Diabetic retinopathy graded by the modified Davis classification
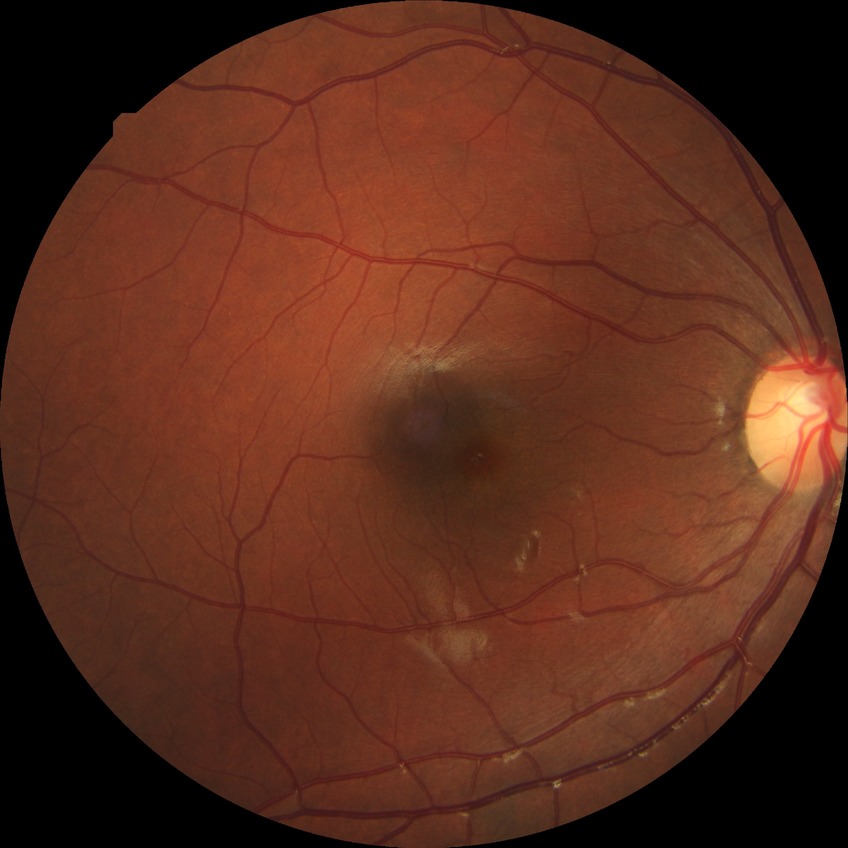
Diabetic retinopathy (DR): no diabetic retinopathy (NDR).